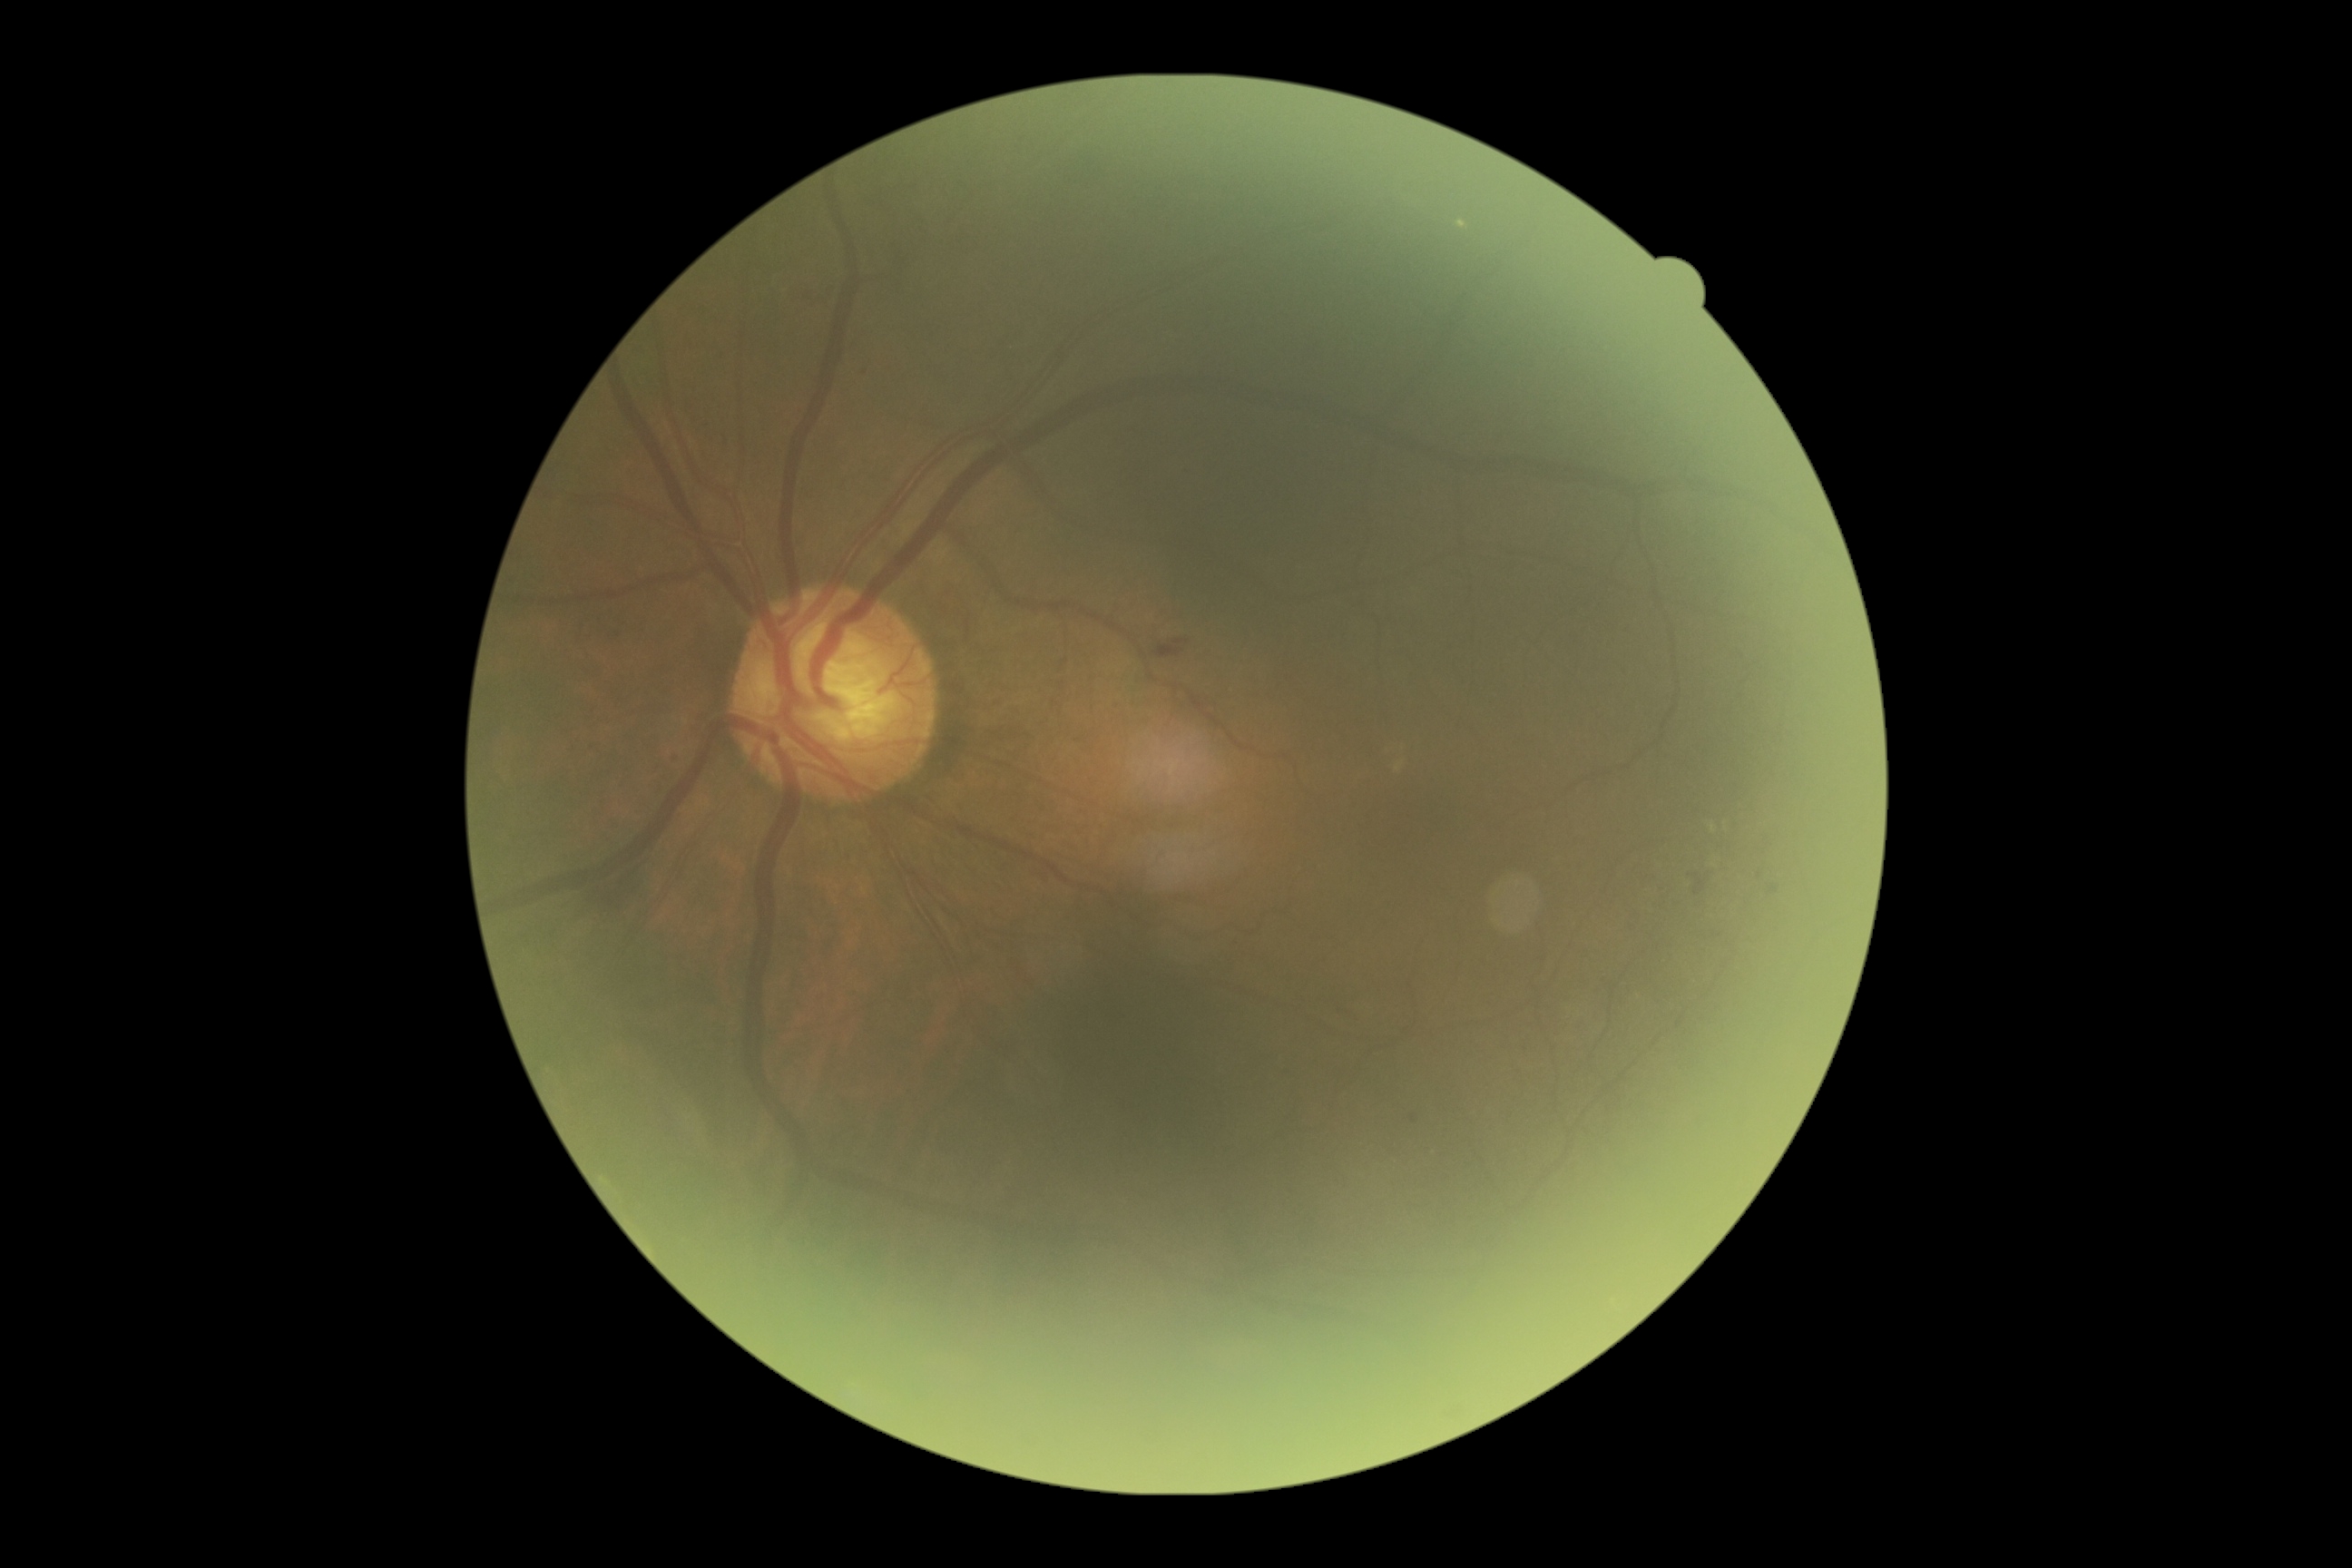

Diabetic retinopathy (DR) is grade 2.